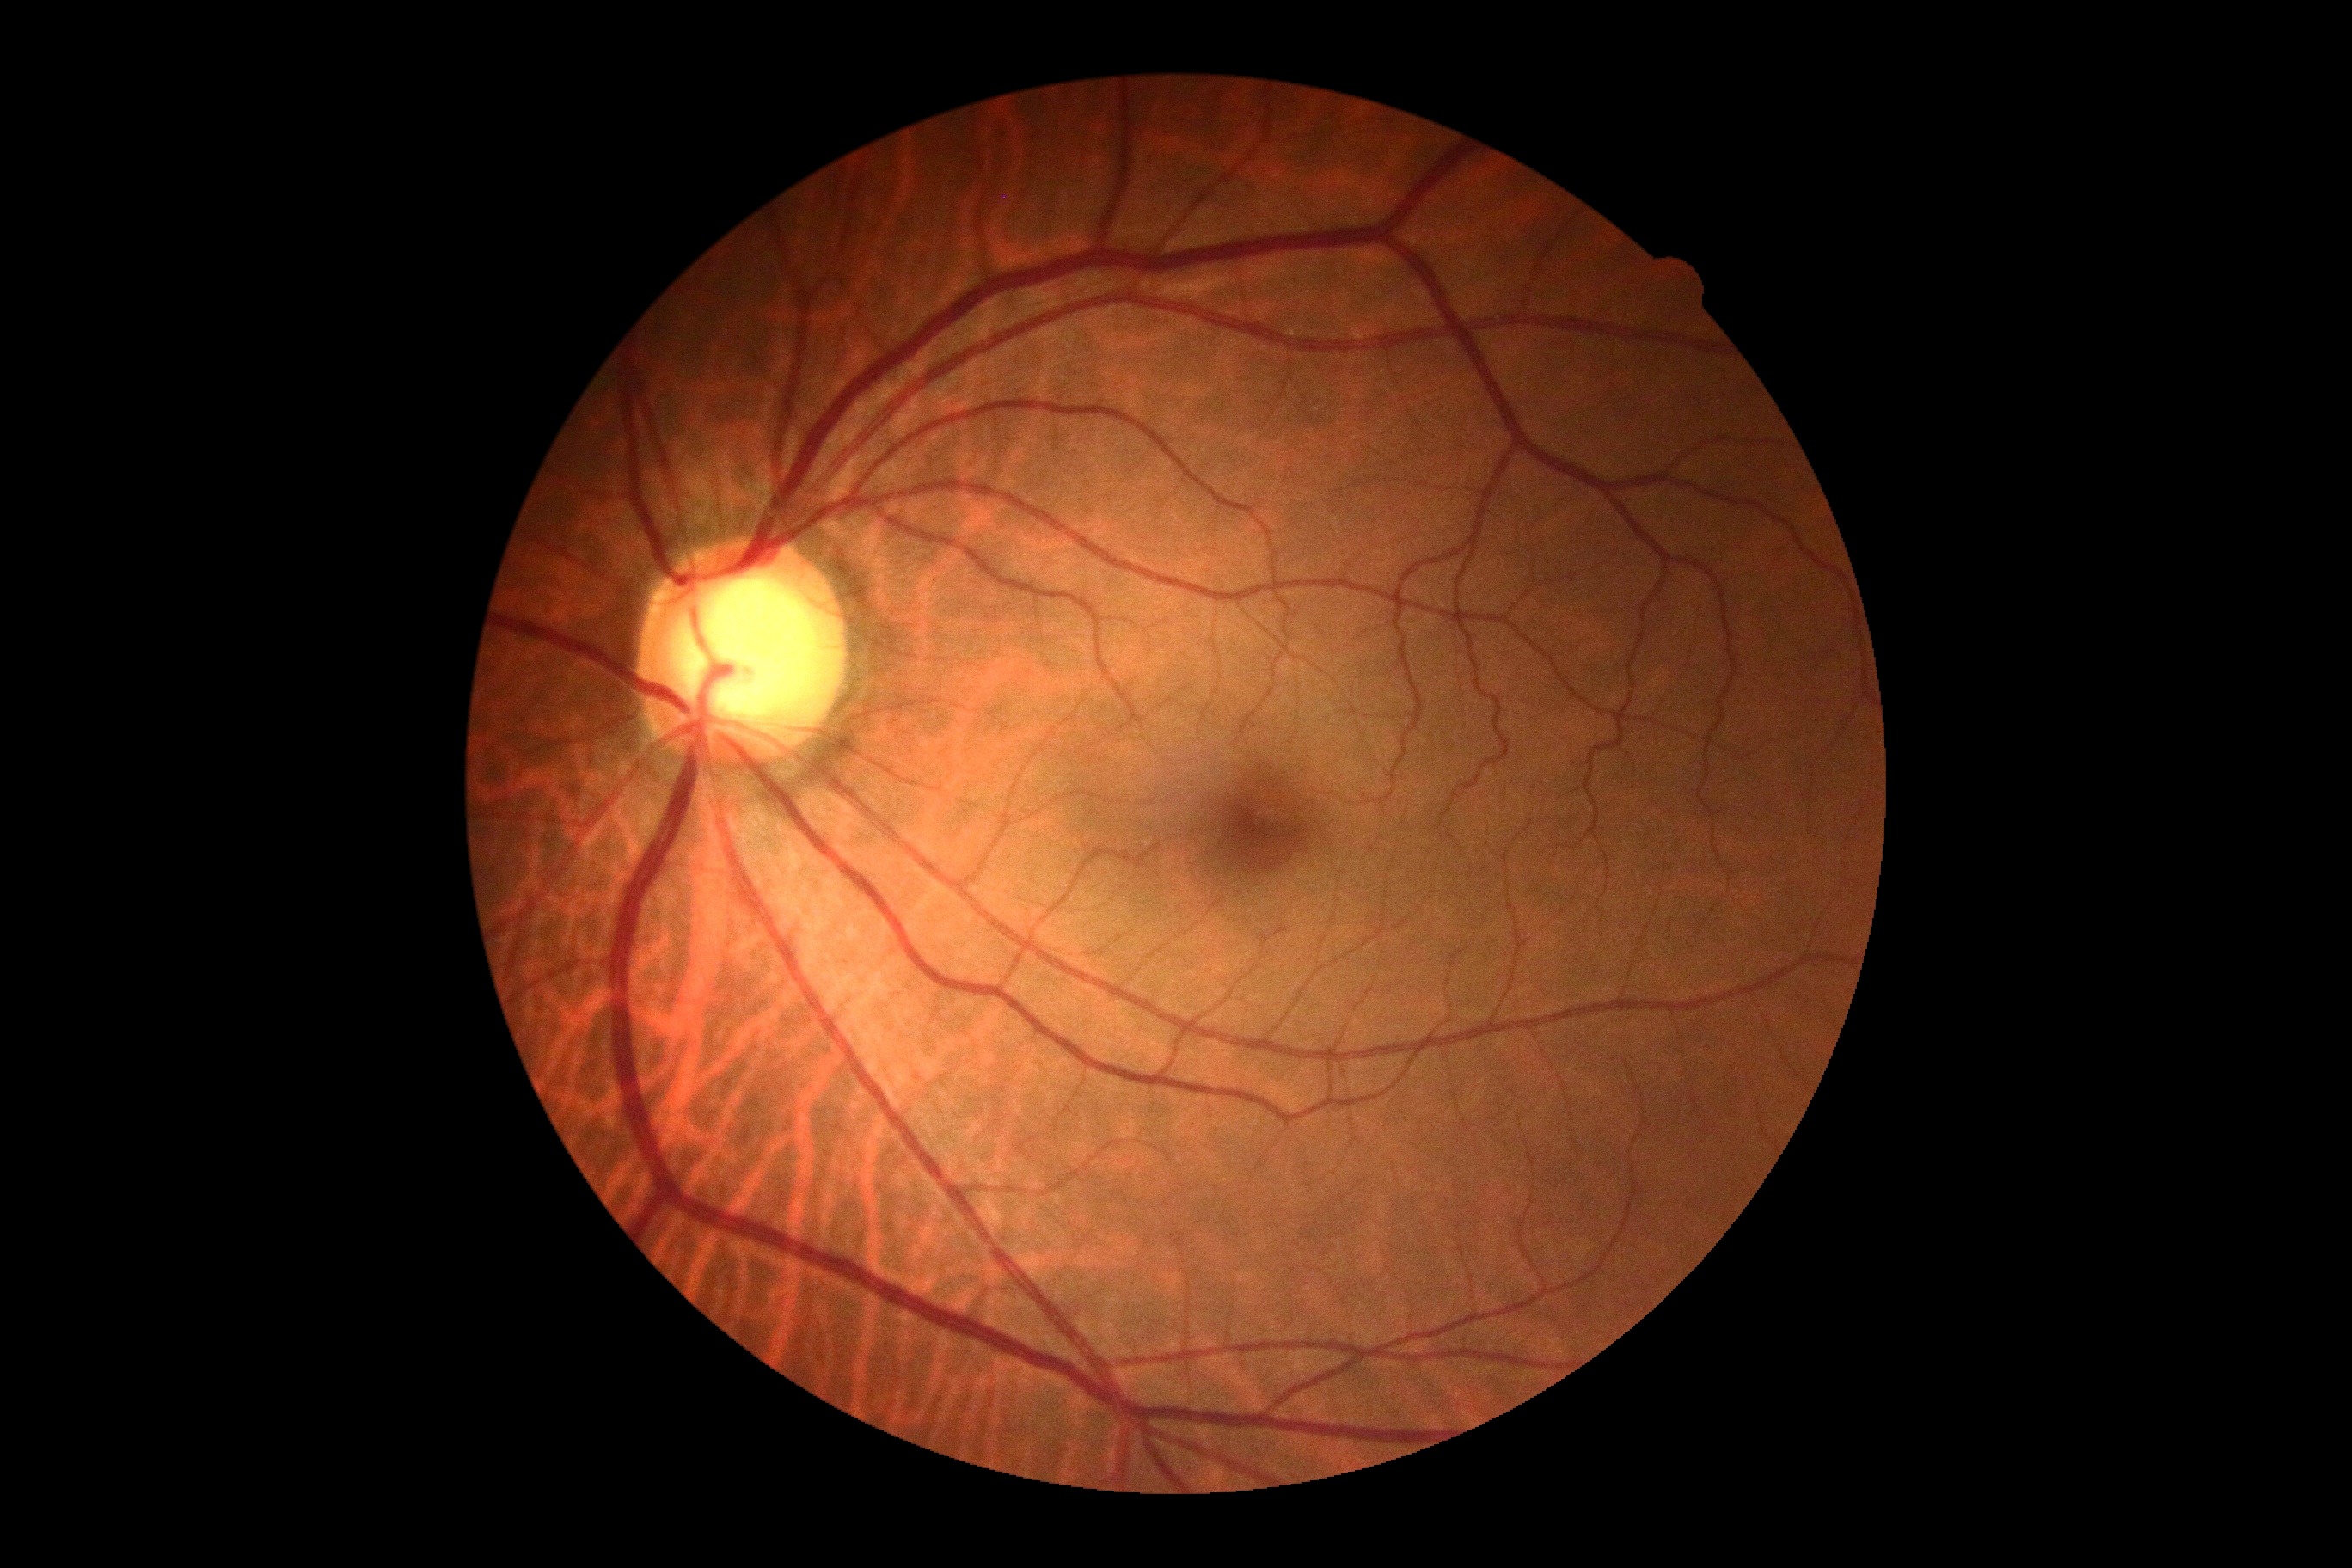 DR: no apparent retinopathy (grade 0).